848 x 848 pixels; NIDEK AFC-230: 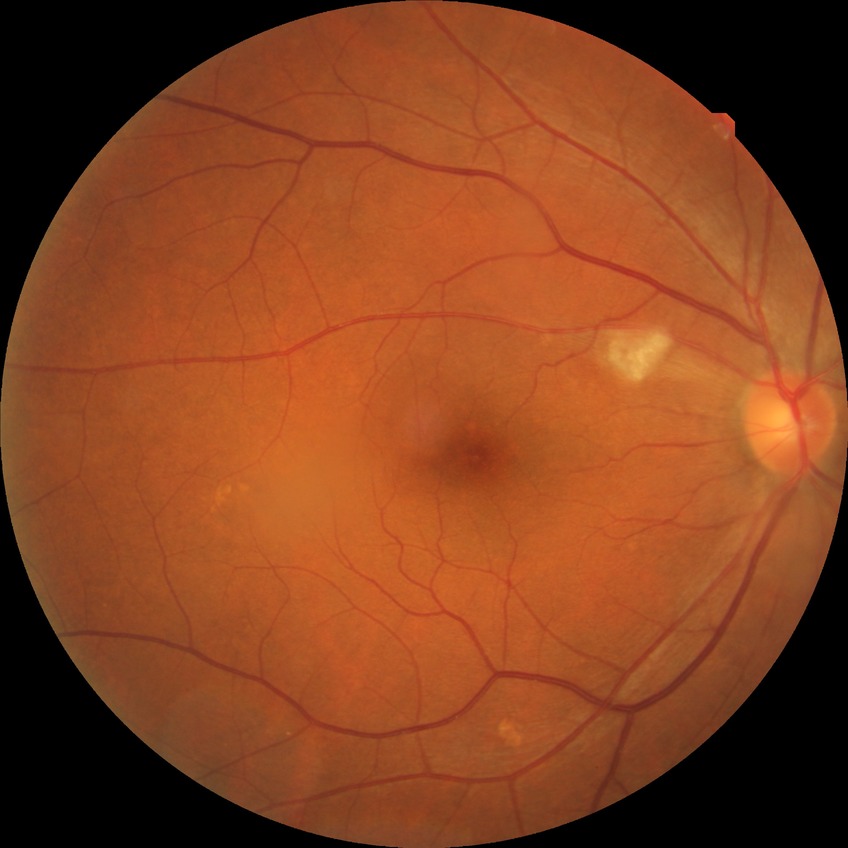
  davis_grade: PPDR
  proliferative_class: non-proliferative diabetic retinopathy